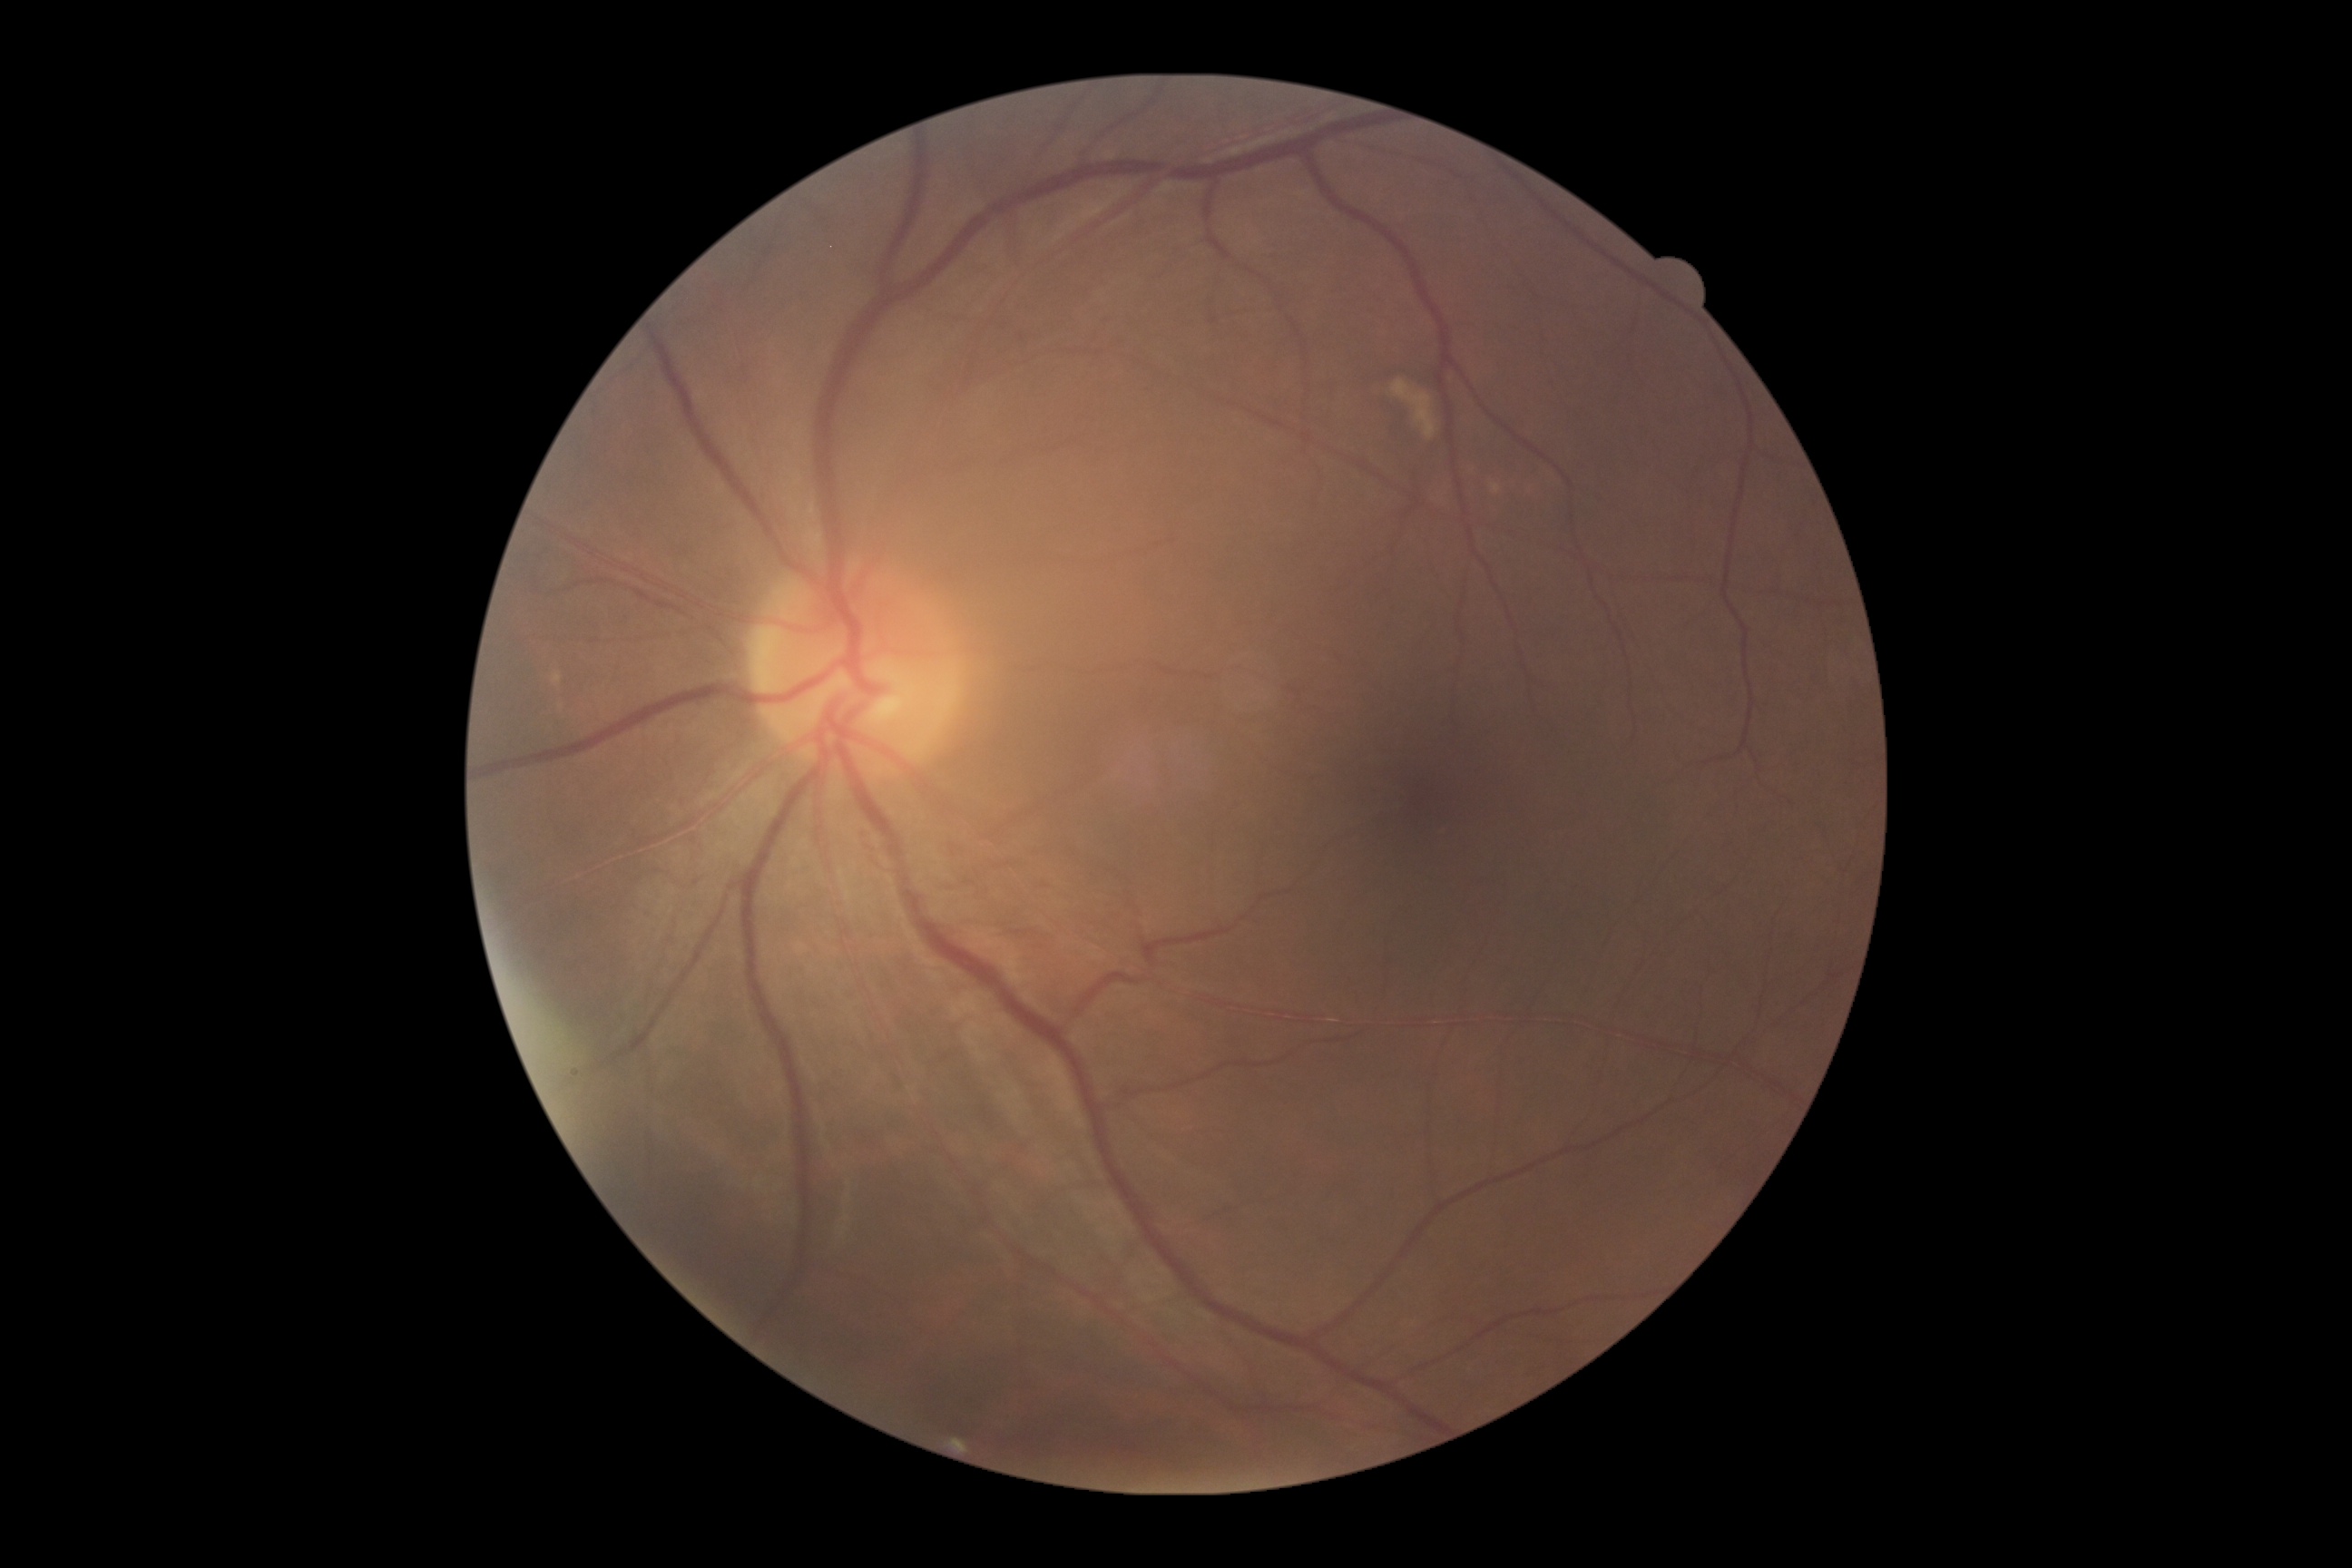
Findings:
– diabetic retinopathy (DR) — grade 0 (no apparent retinopathy) — no visible signs of diabetic retinopathy